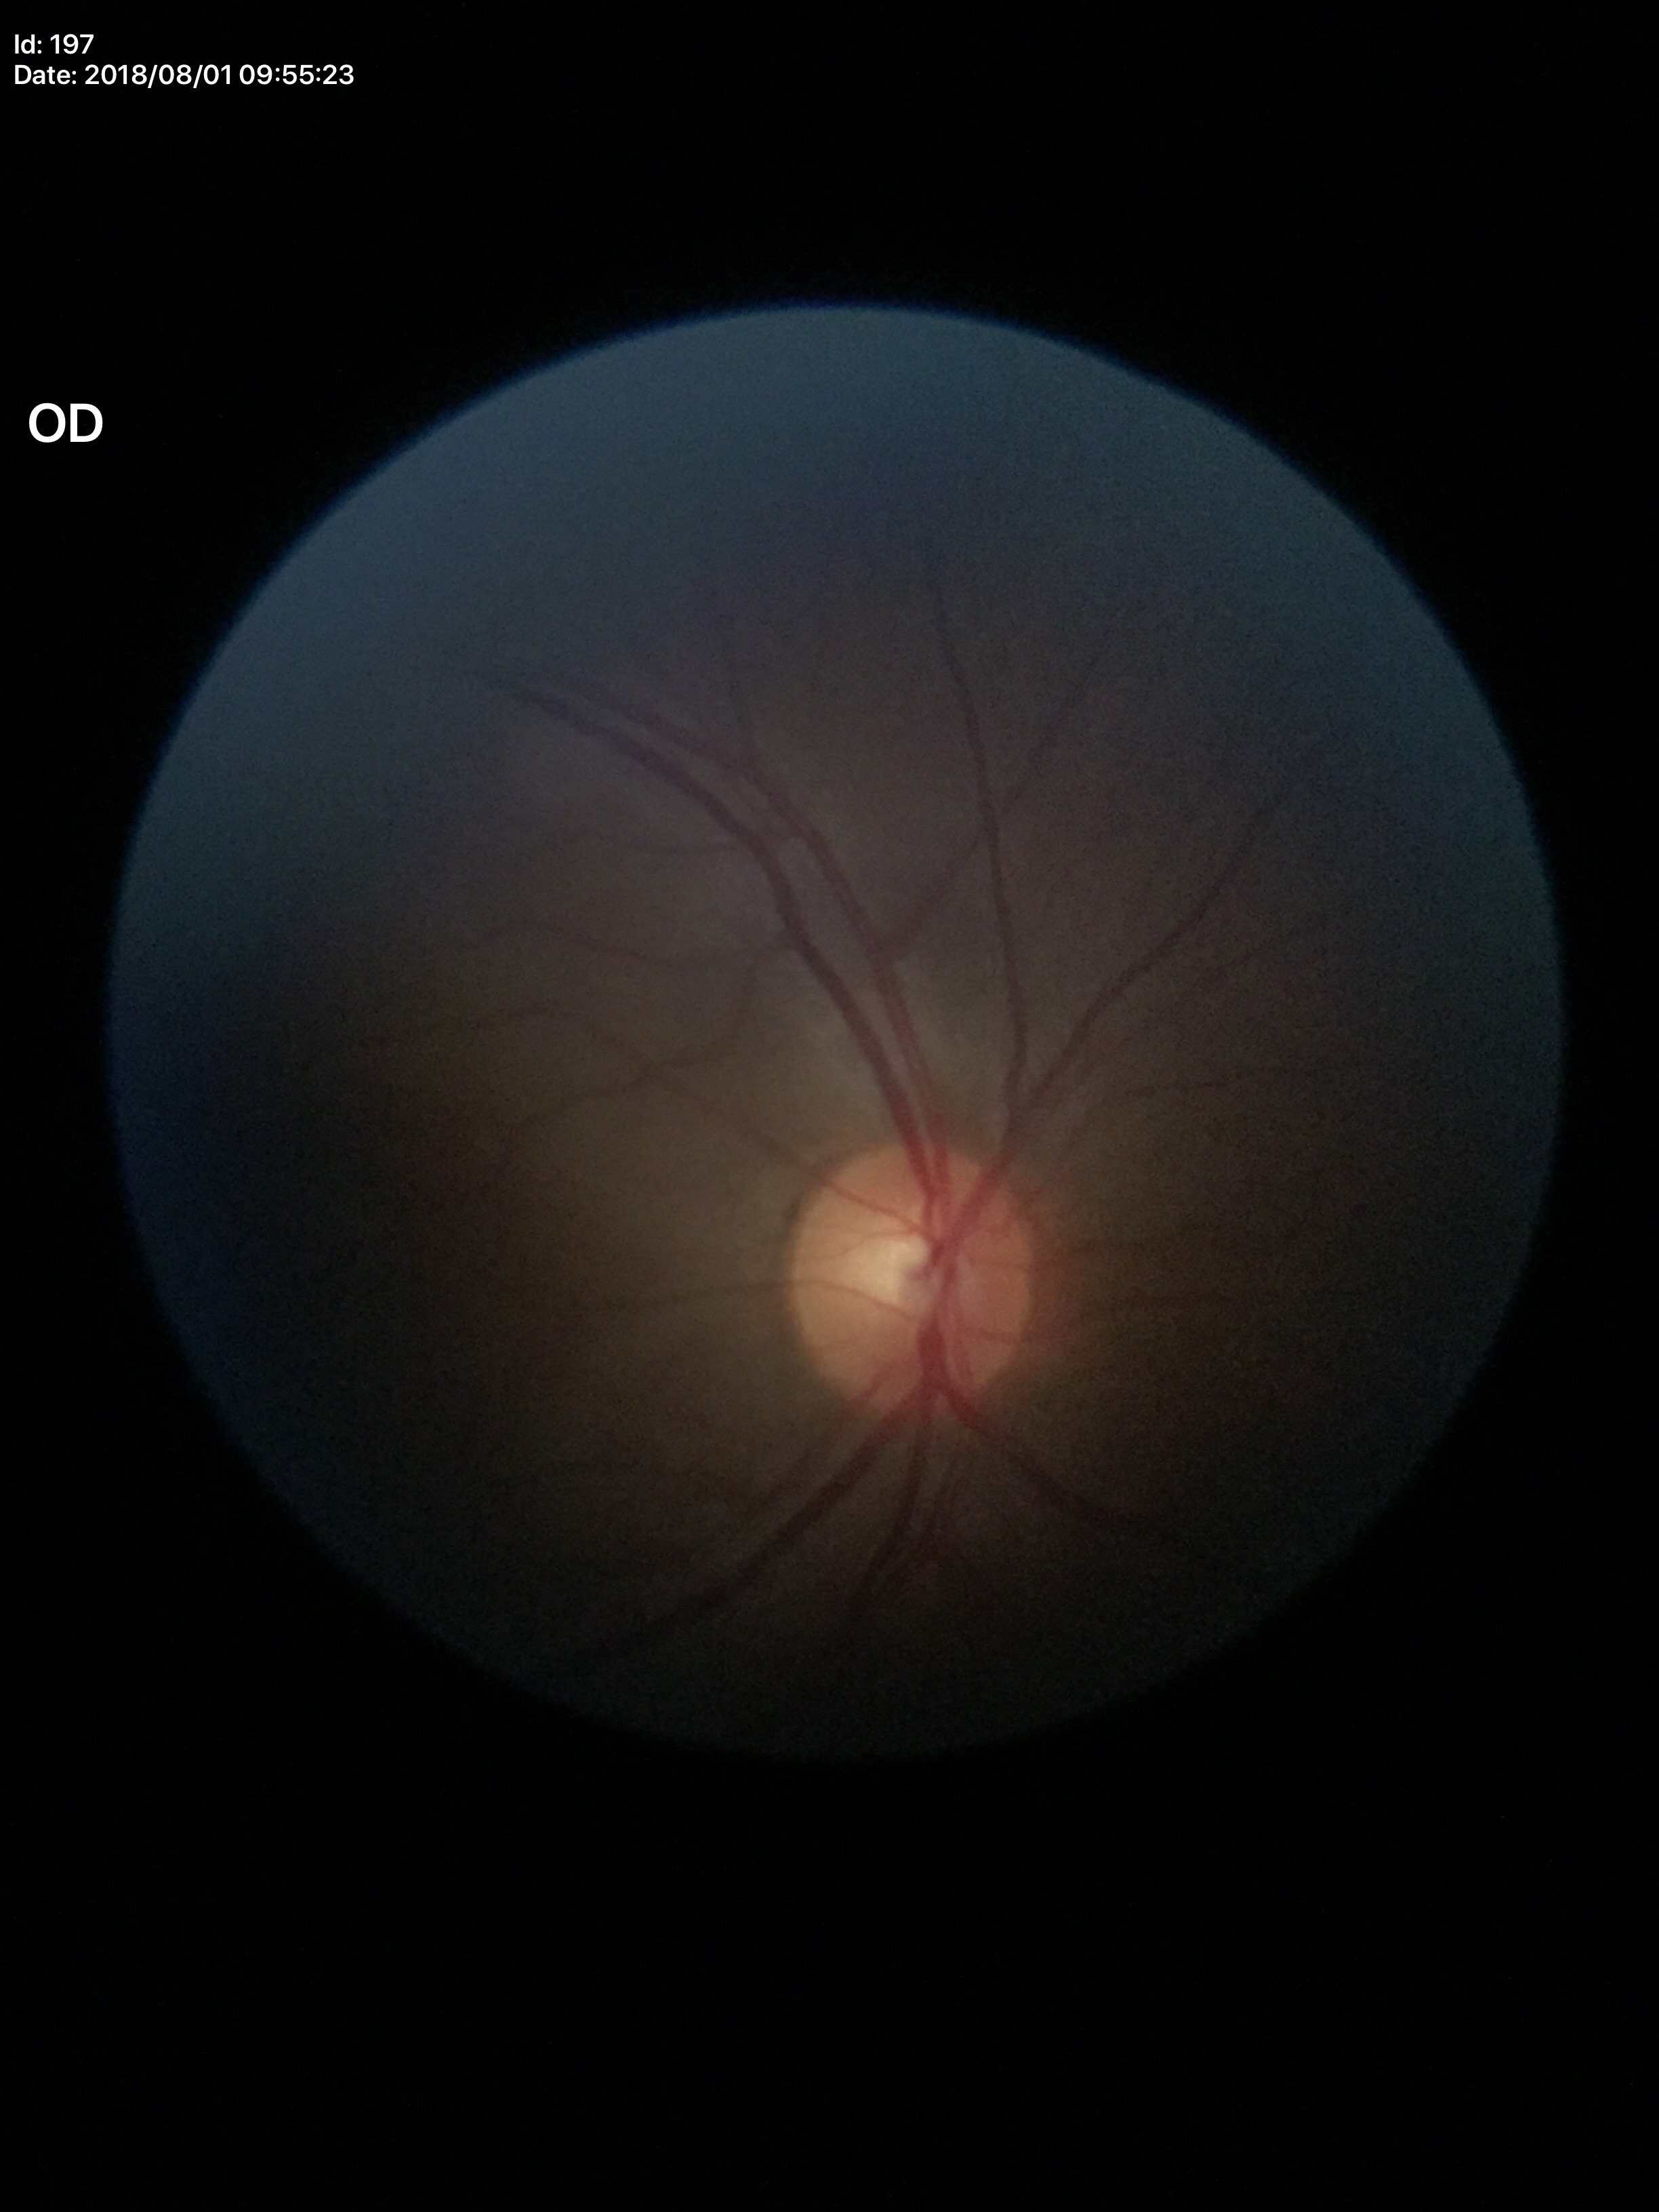

Q: Vertical CDR?
A: 0.49
Q: Glaucoma screening result?
A: not suspect (unanimous normal call)
Q: What is the area cup-to-disc ratio?
A: 0.25
Q: What is the horizontal cup-to-disc ratio?
A: 0.51